Color fundus image:
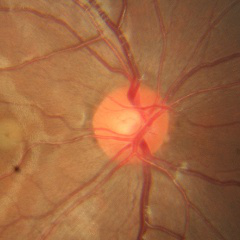

Glaucoma diagnosis = no glaucomatous changes.